45-degree field of view.
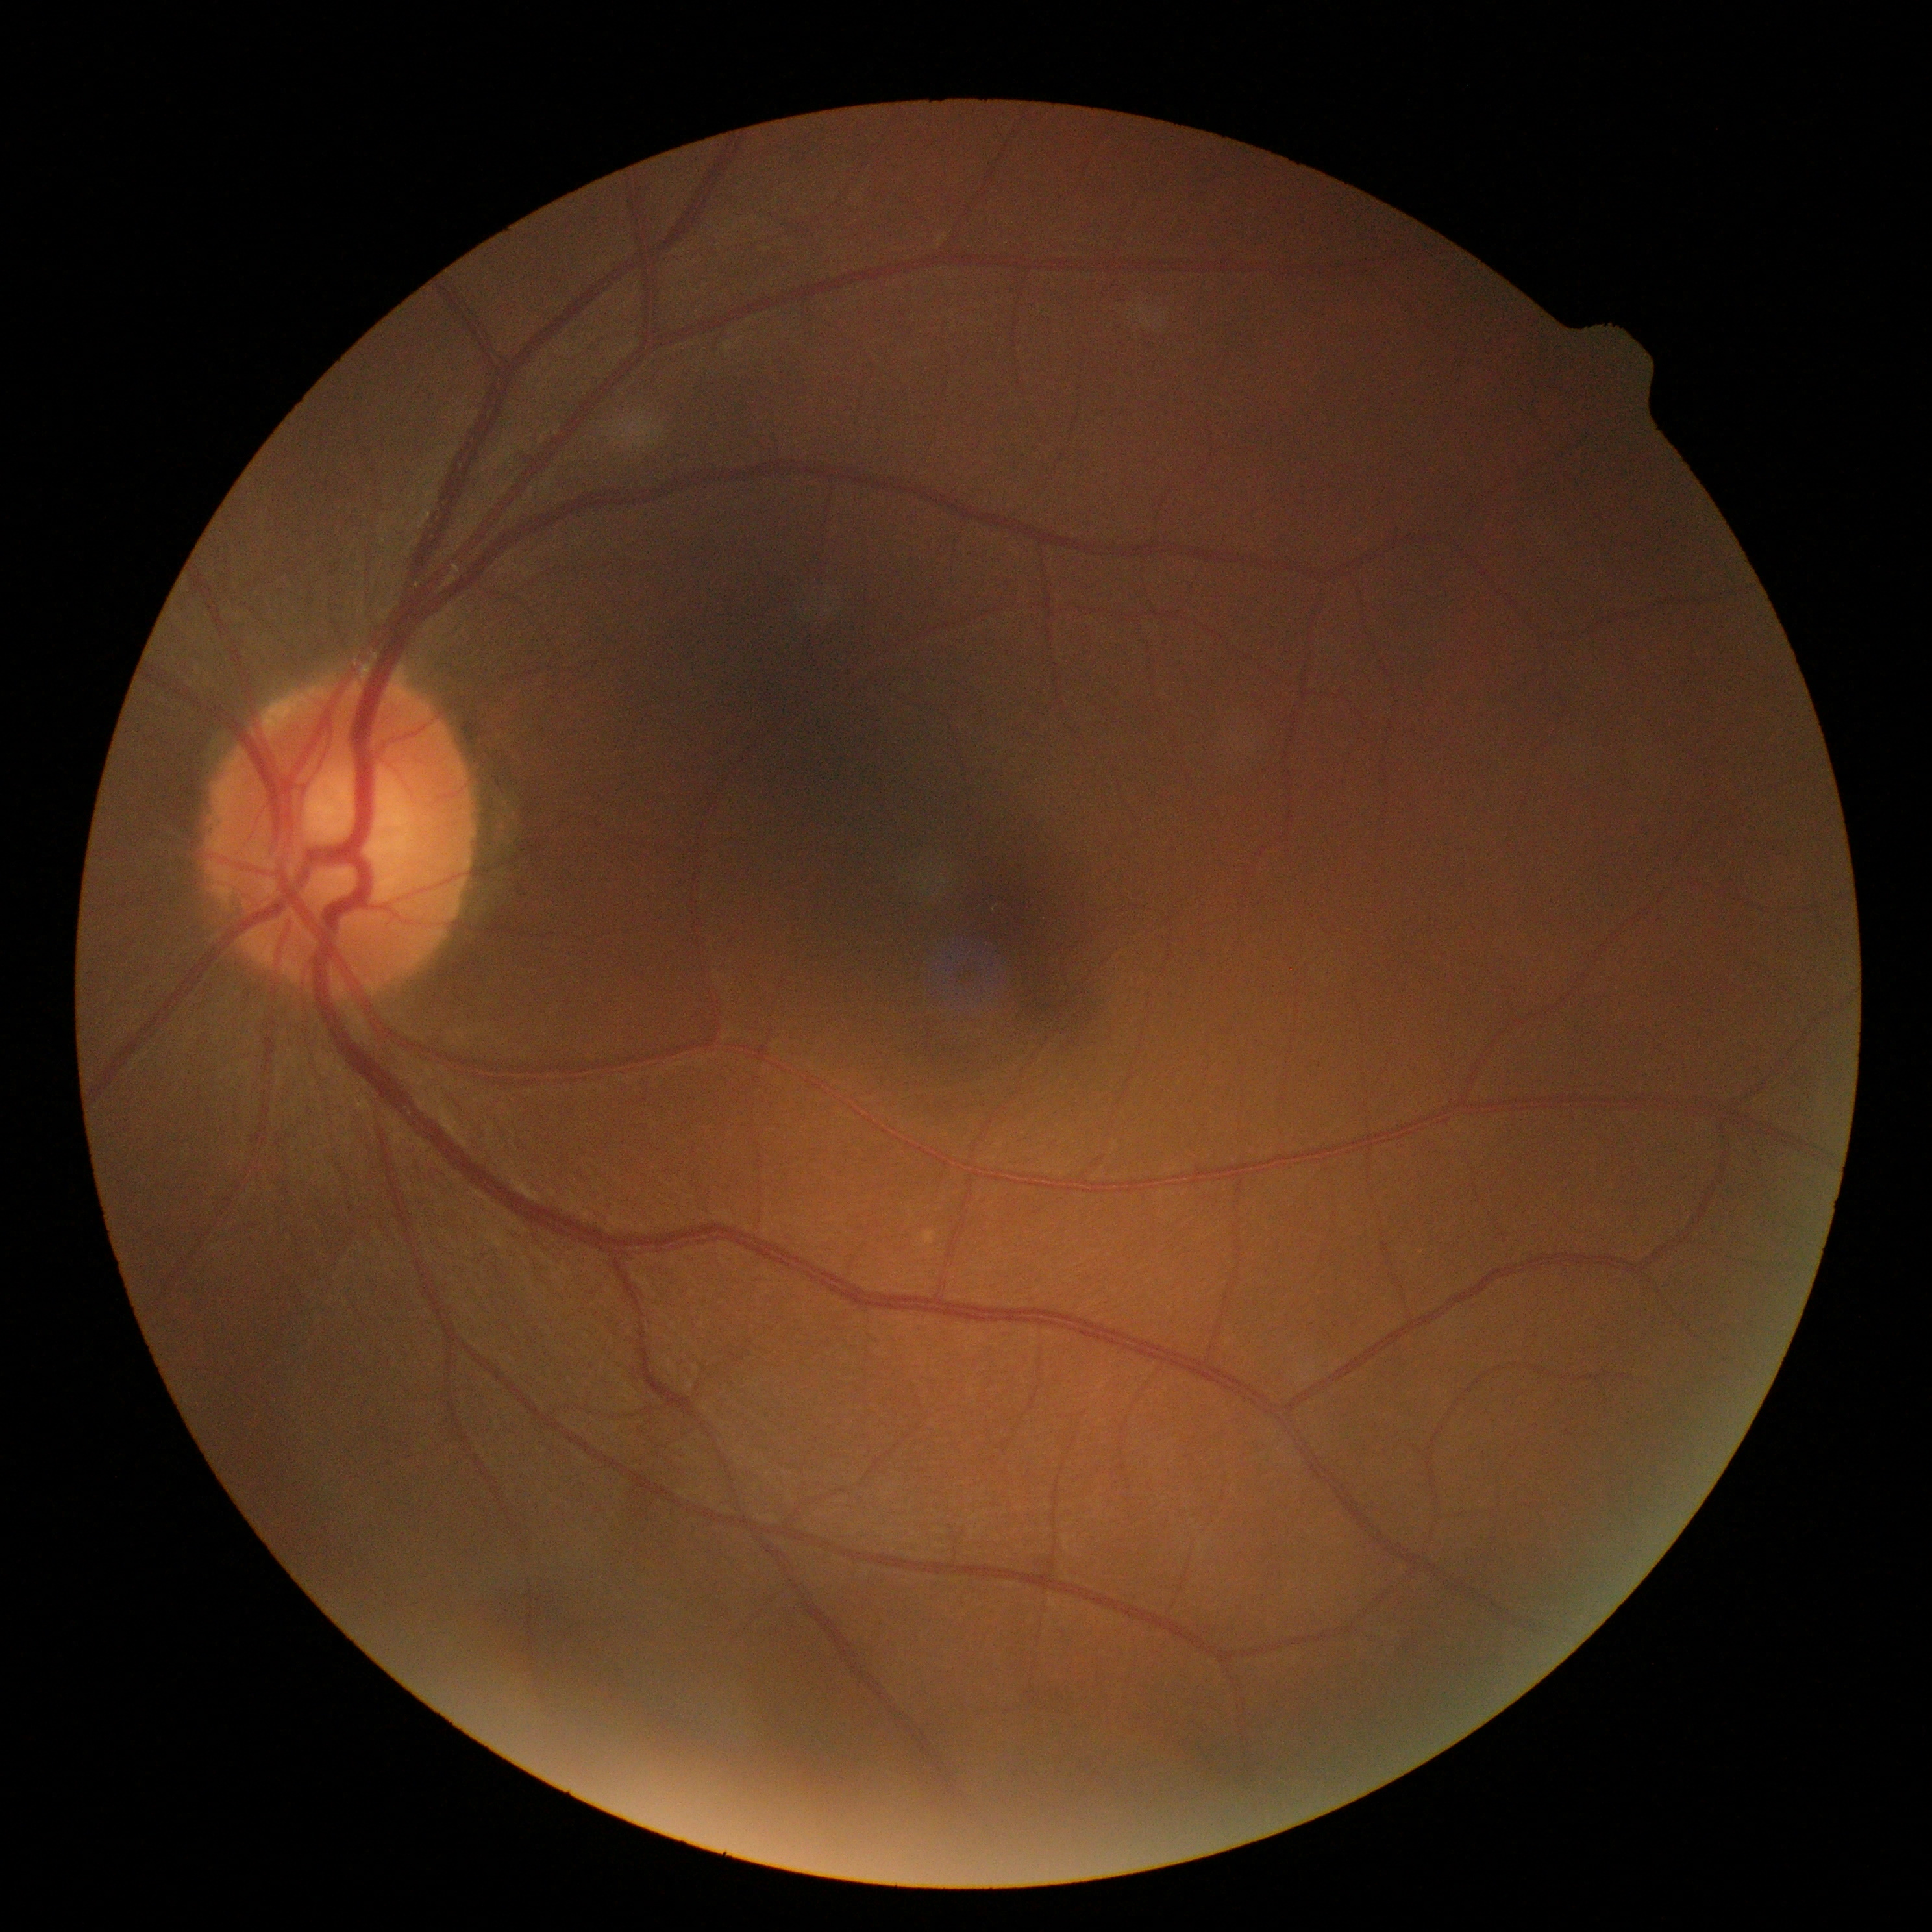 Diabetic retinopathy grade: 0/4 — no visible signs of diabetic retinopathy. No apparent diabetic retinopathy.